CFP — 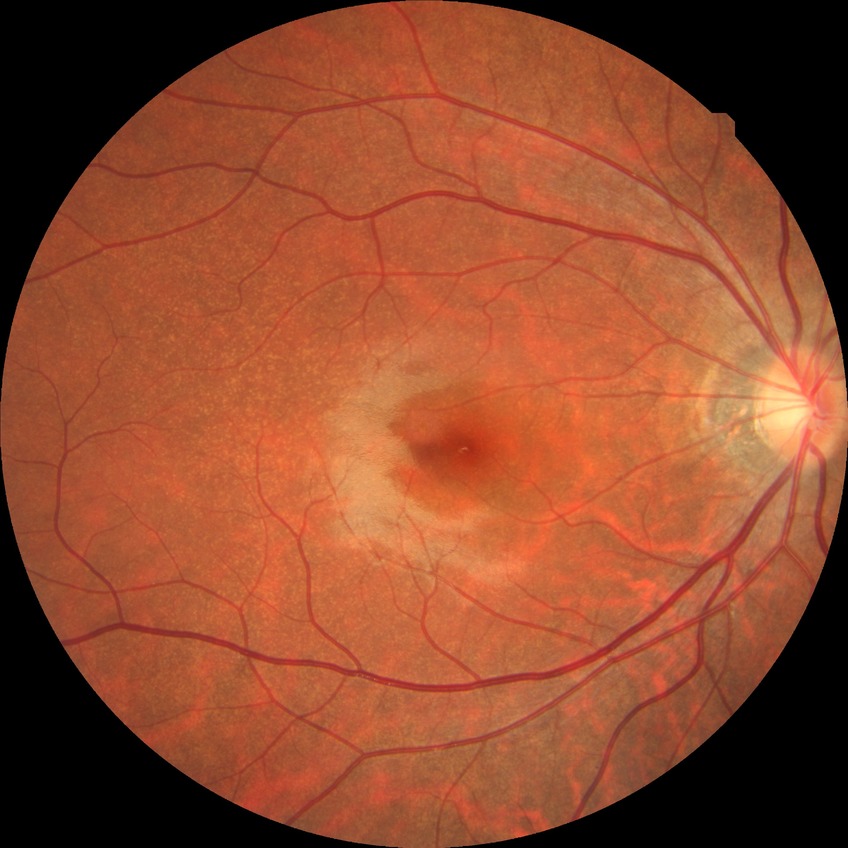 diabetic retinopathy (DR) = NDR (no diabetic retinopathy)